Davis DR grading, no pharmacologic dilation — 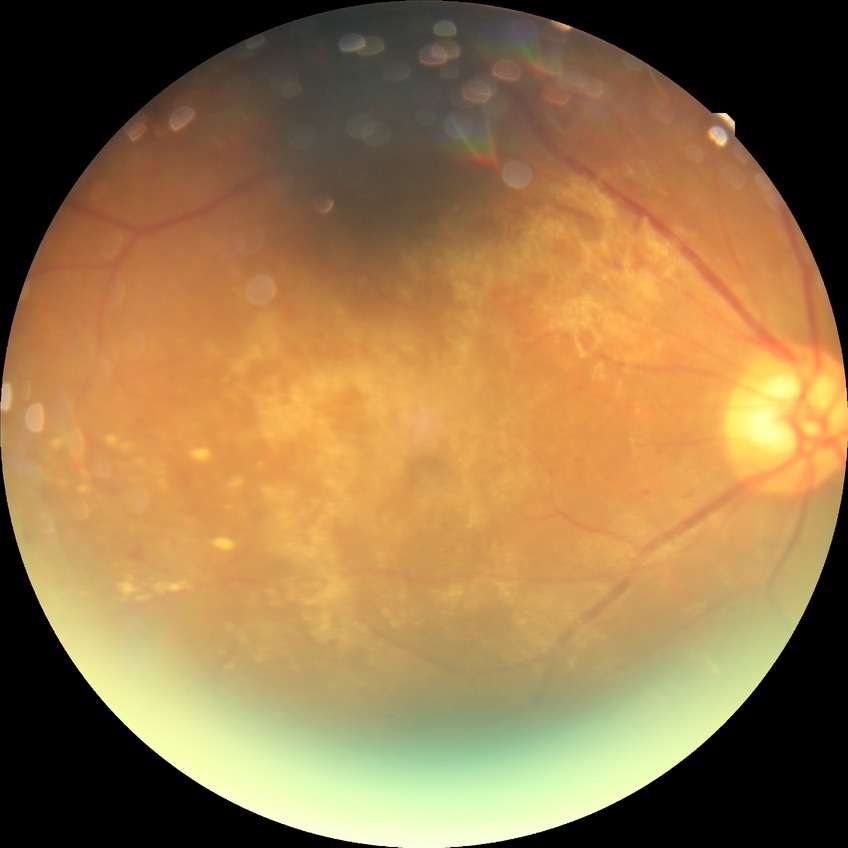
Diabetic retinopathy (DR): PDR (proliferative diabetic retinopathy).